No pharmacologic dilation; color fundus image; 45° field of view — 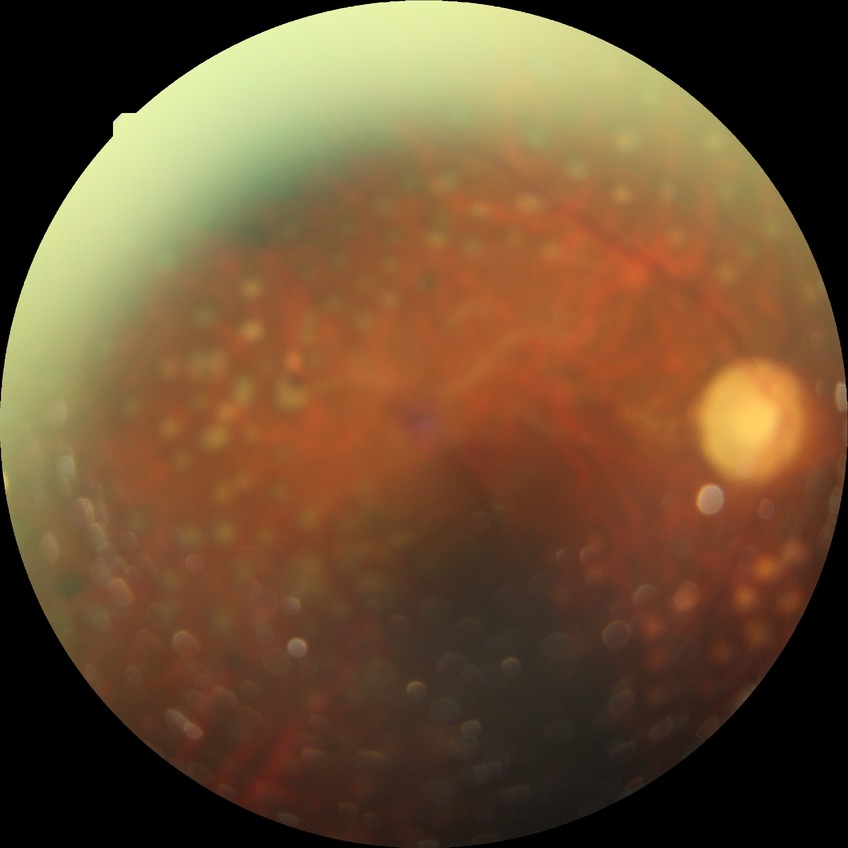

Retinopathy grade is proliferative diabetic retinopathy.